2352 by 1568 pixels.
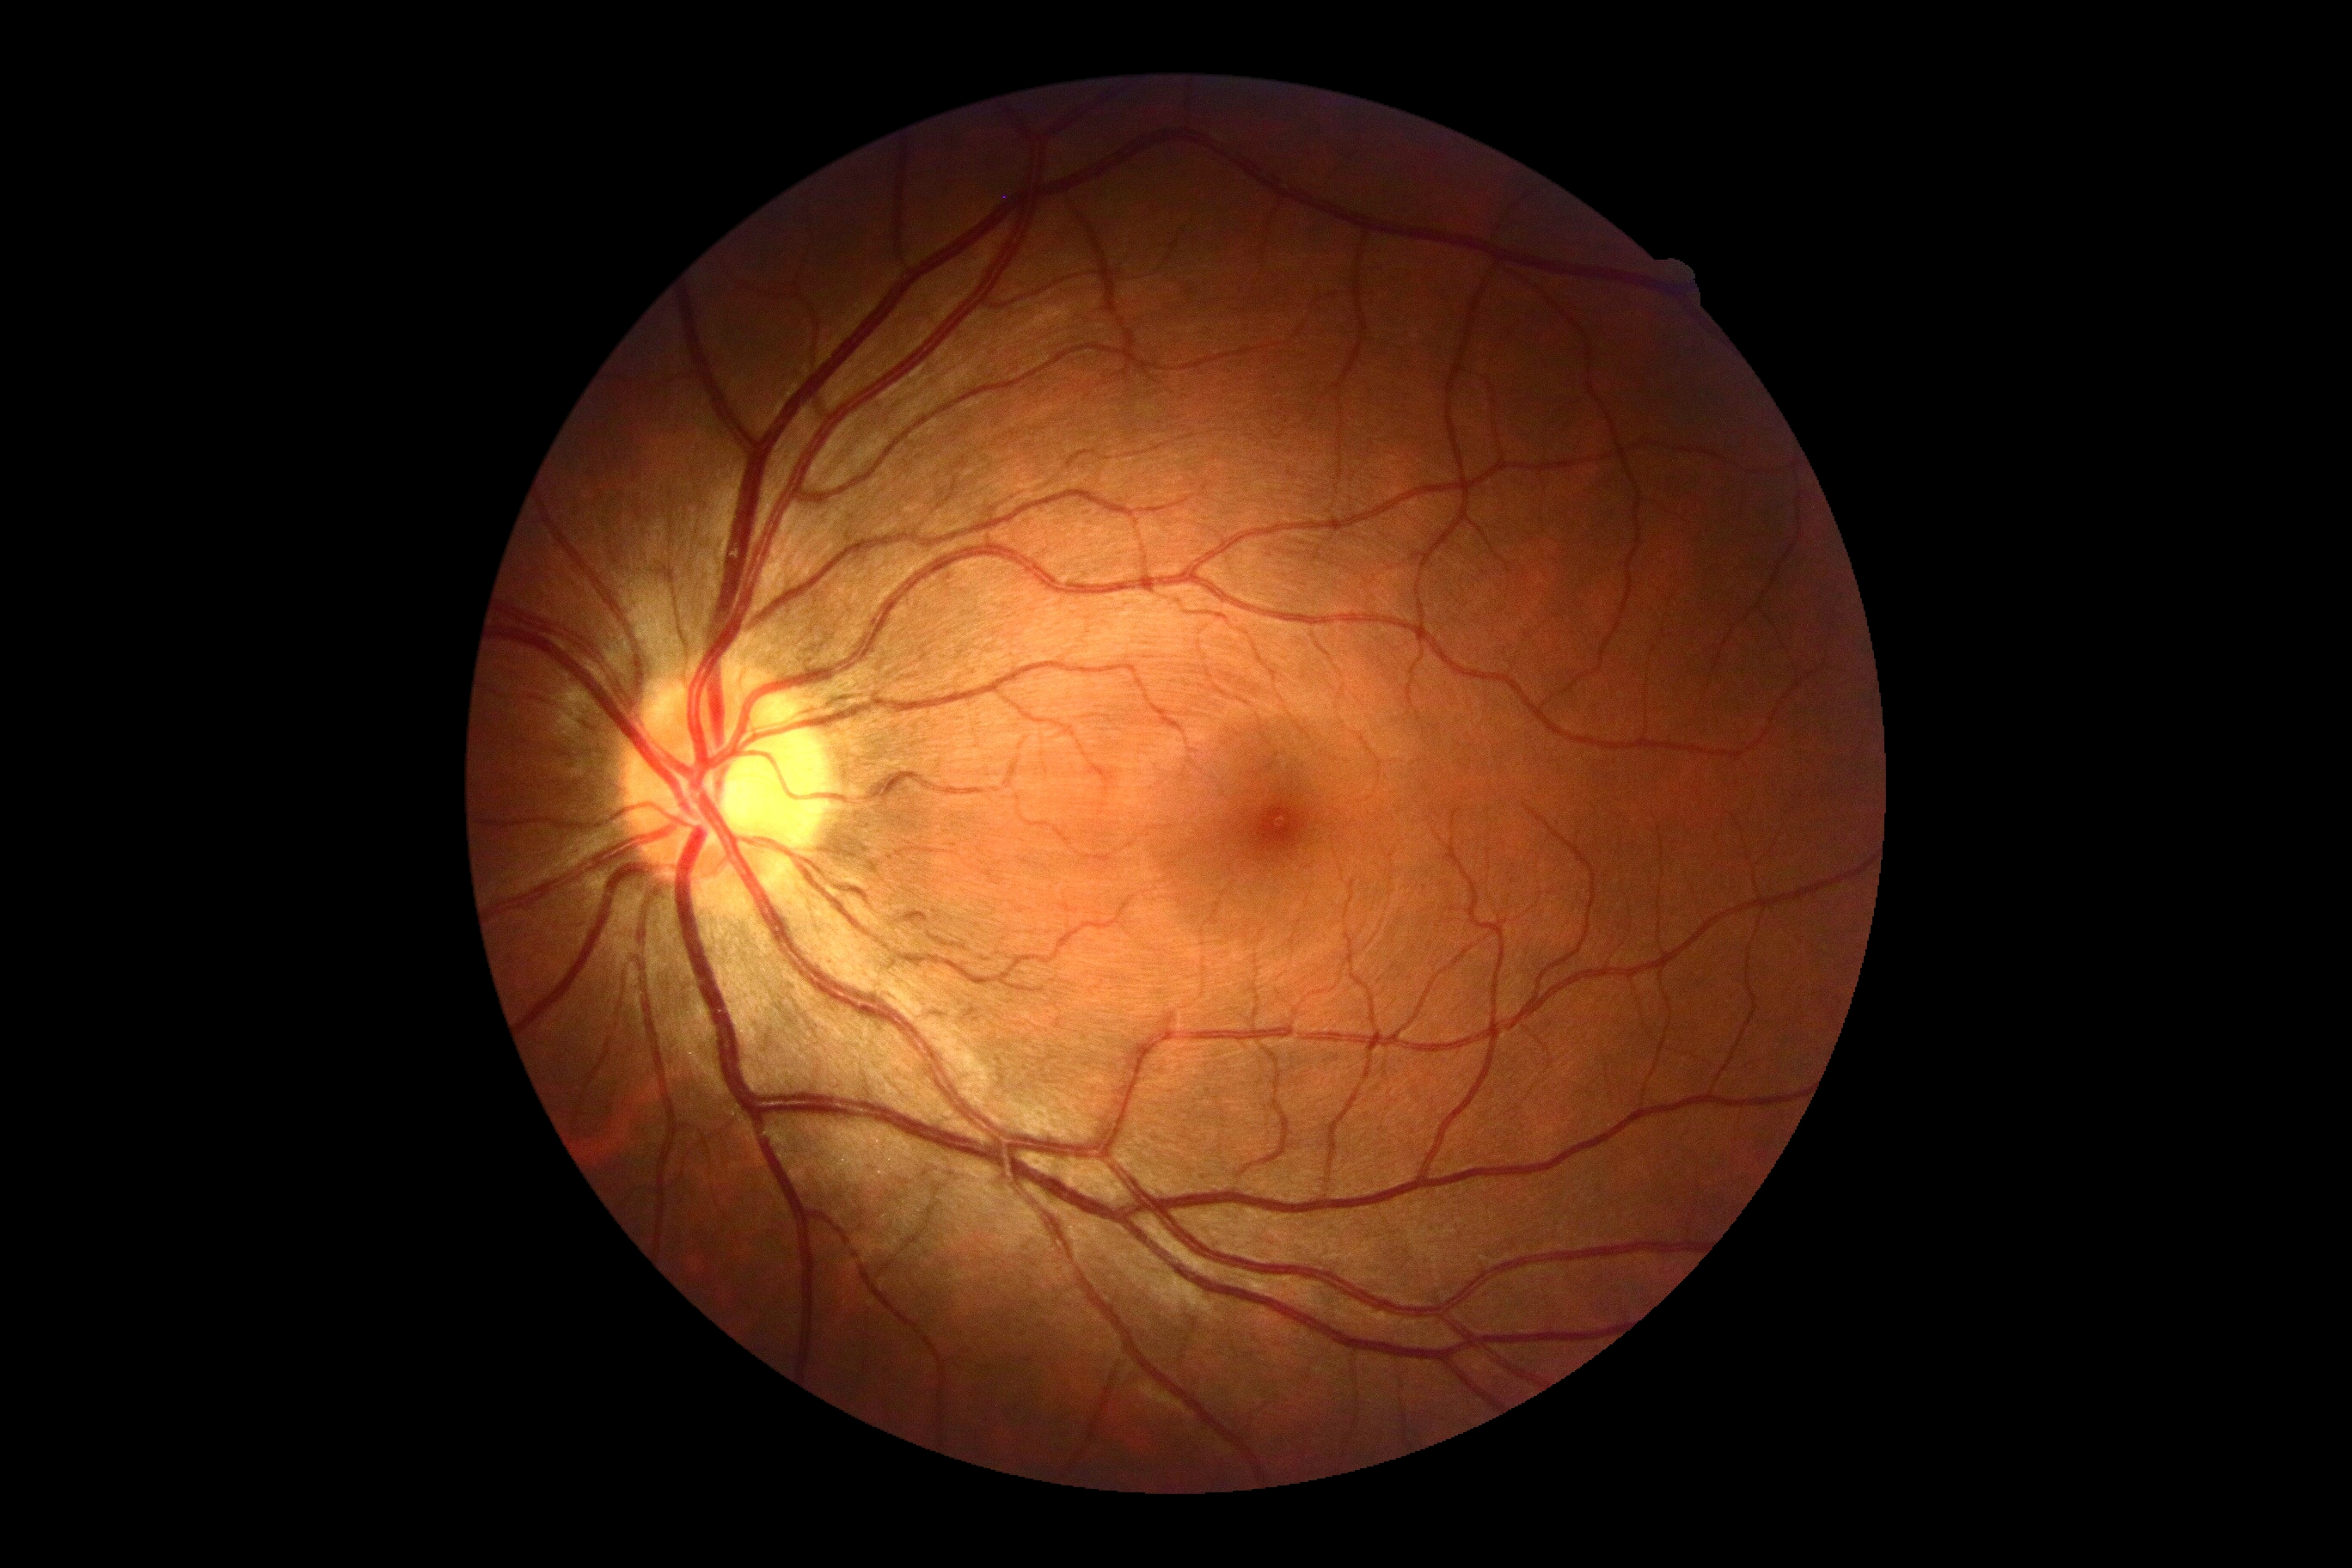 No apparent diabetic retinopathy. DR stage is grade 0 (no apparent retinopathy).